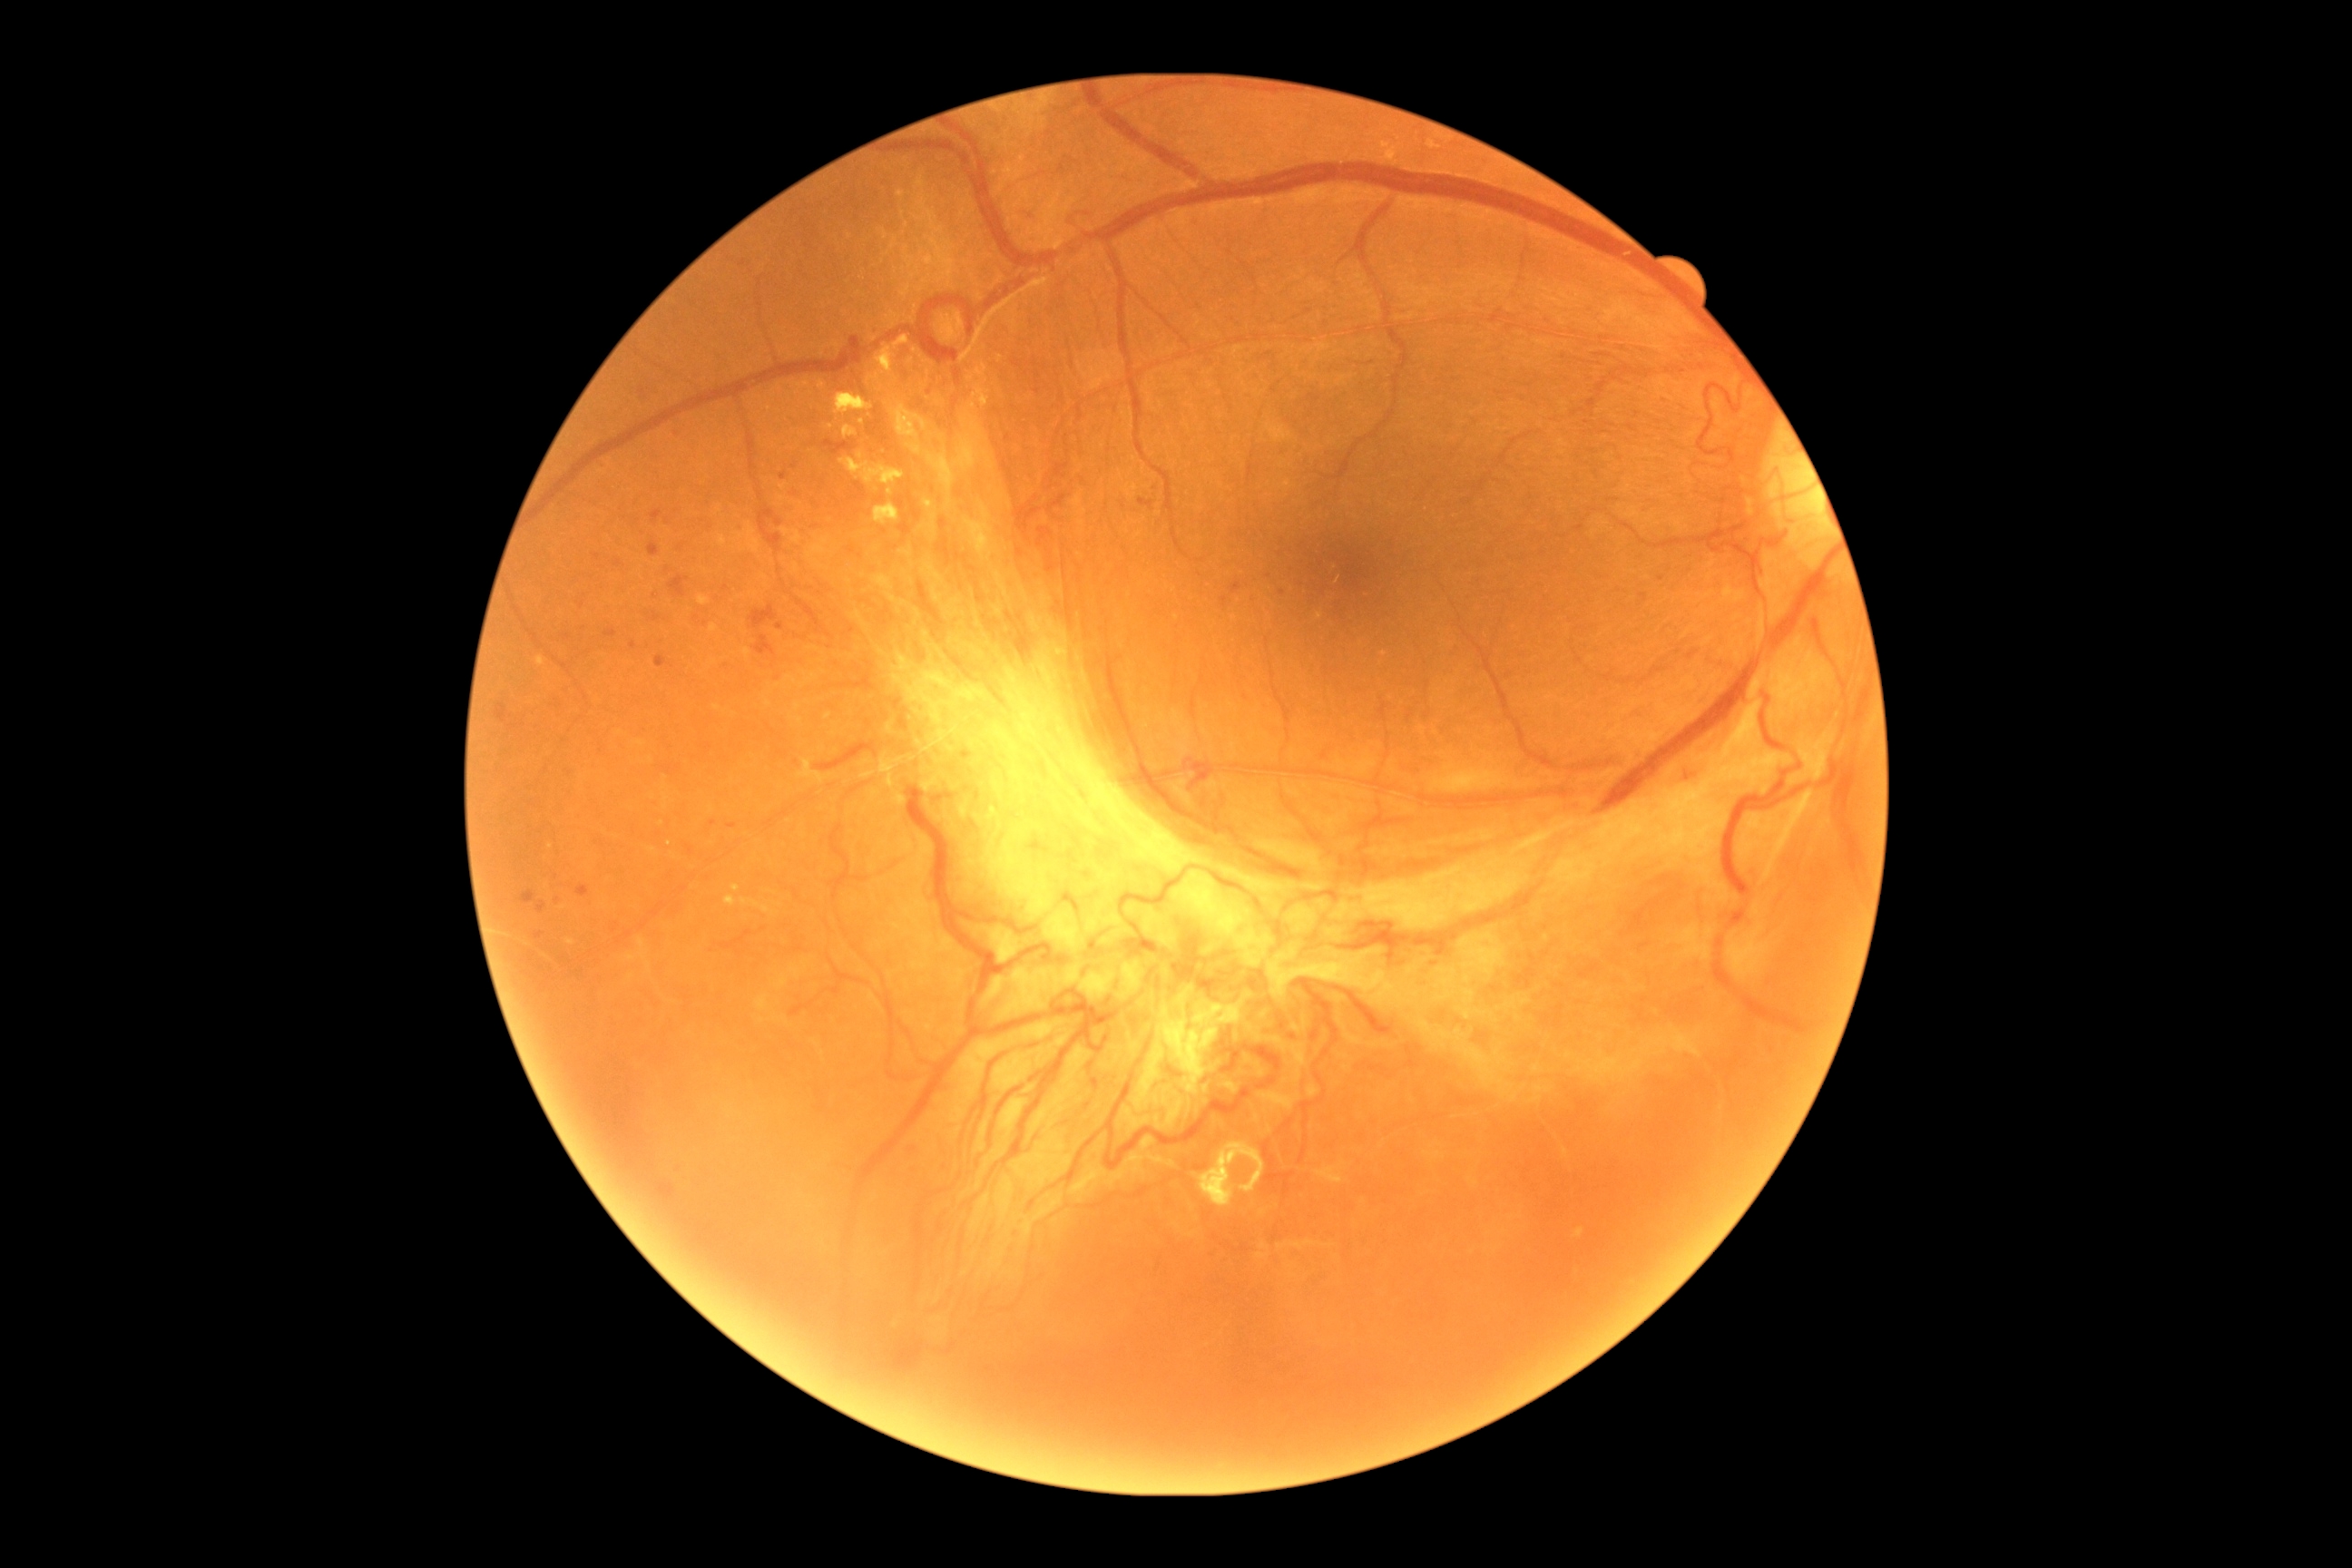 DR stage: proliferative diabetic retinopathy (grade 4).